Pediatric retinal photograph (wide-field). 100° field of view (Phoenix ICON): 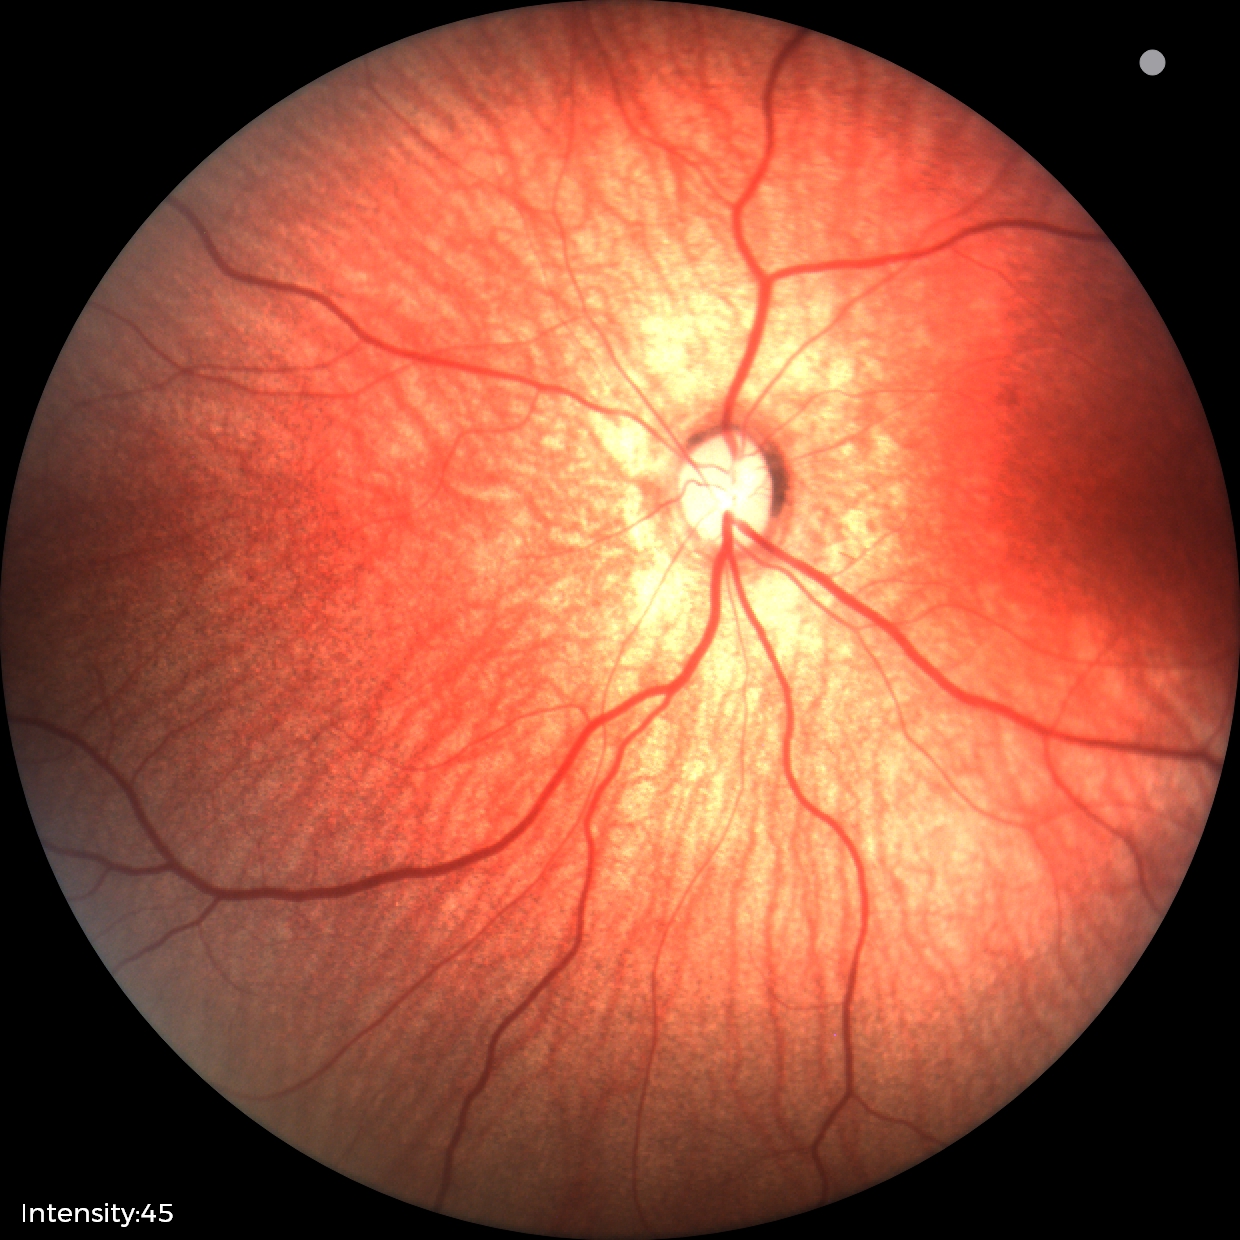

Examination with physiological retinal findings.